Color fundus image, 45° field of view — 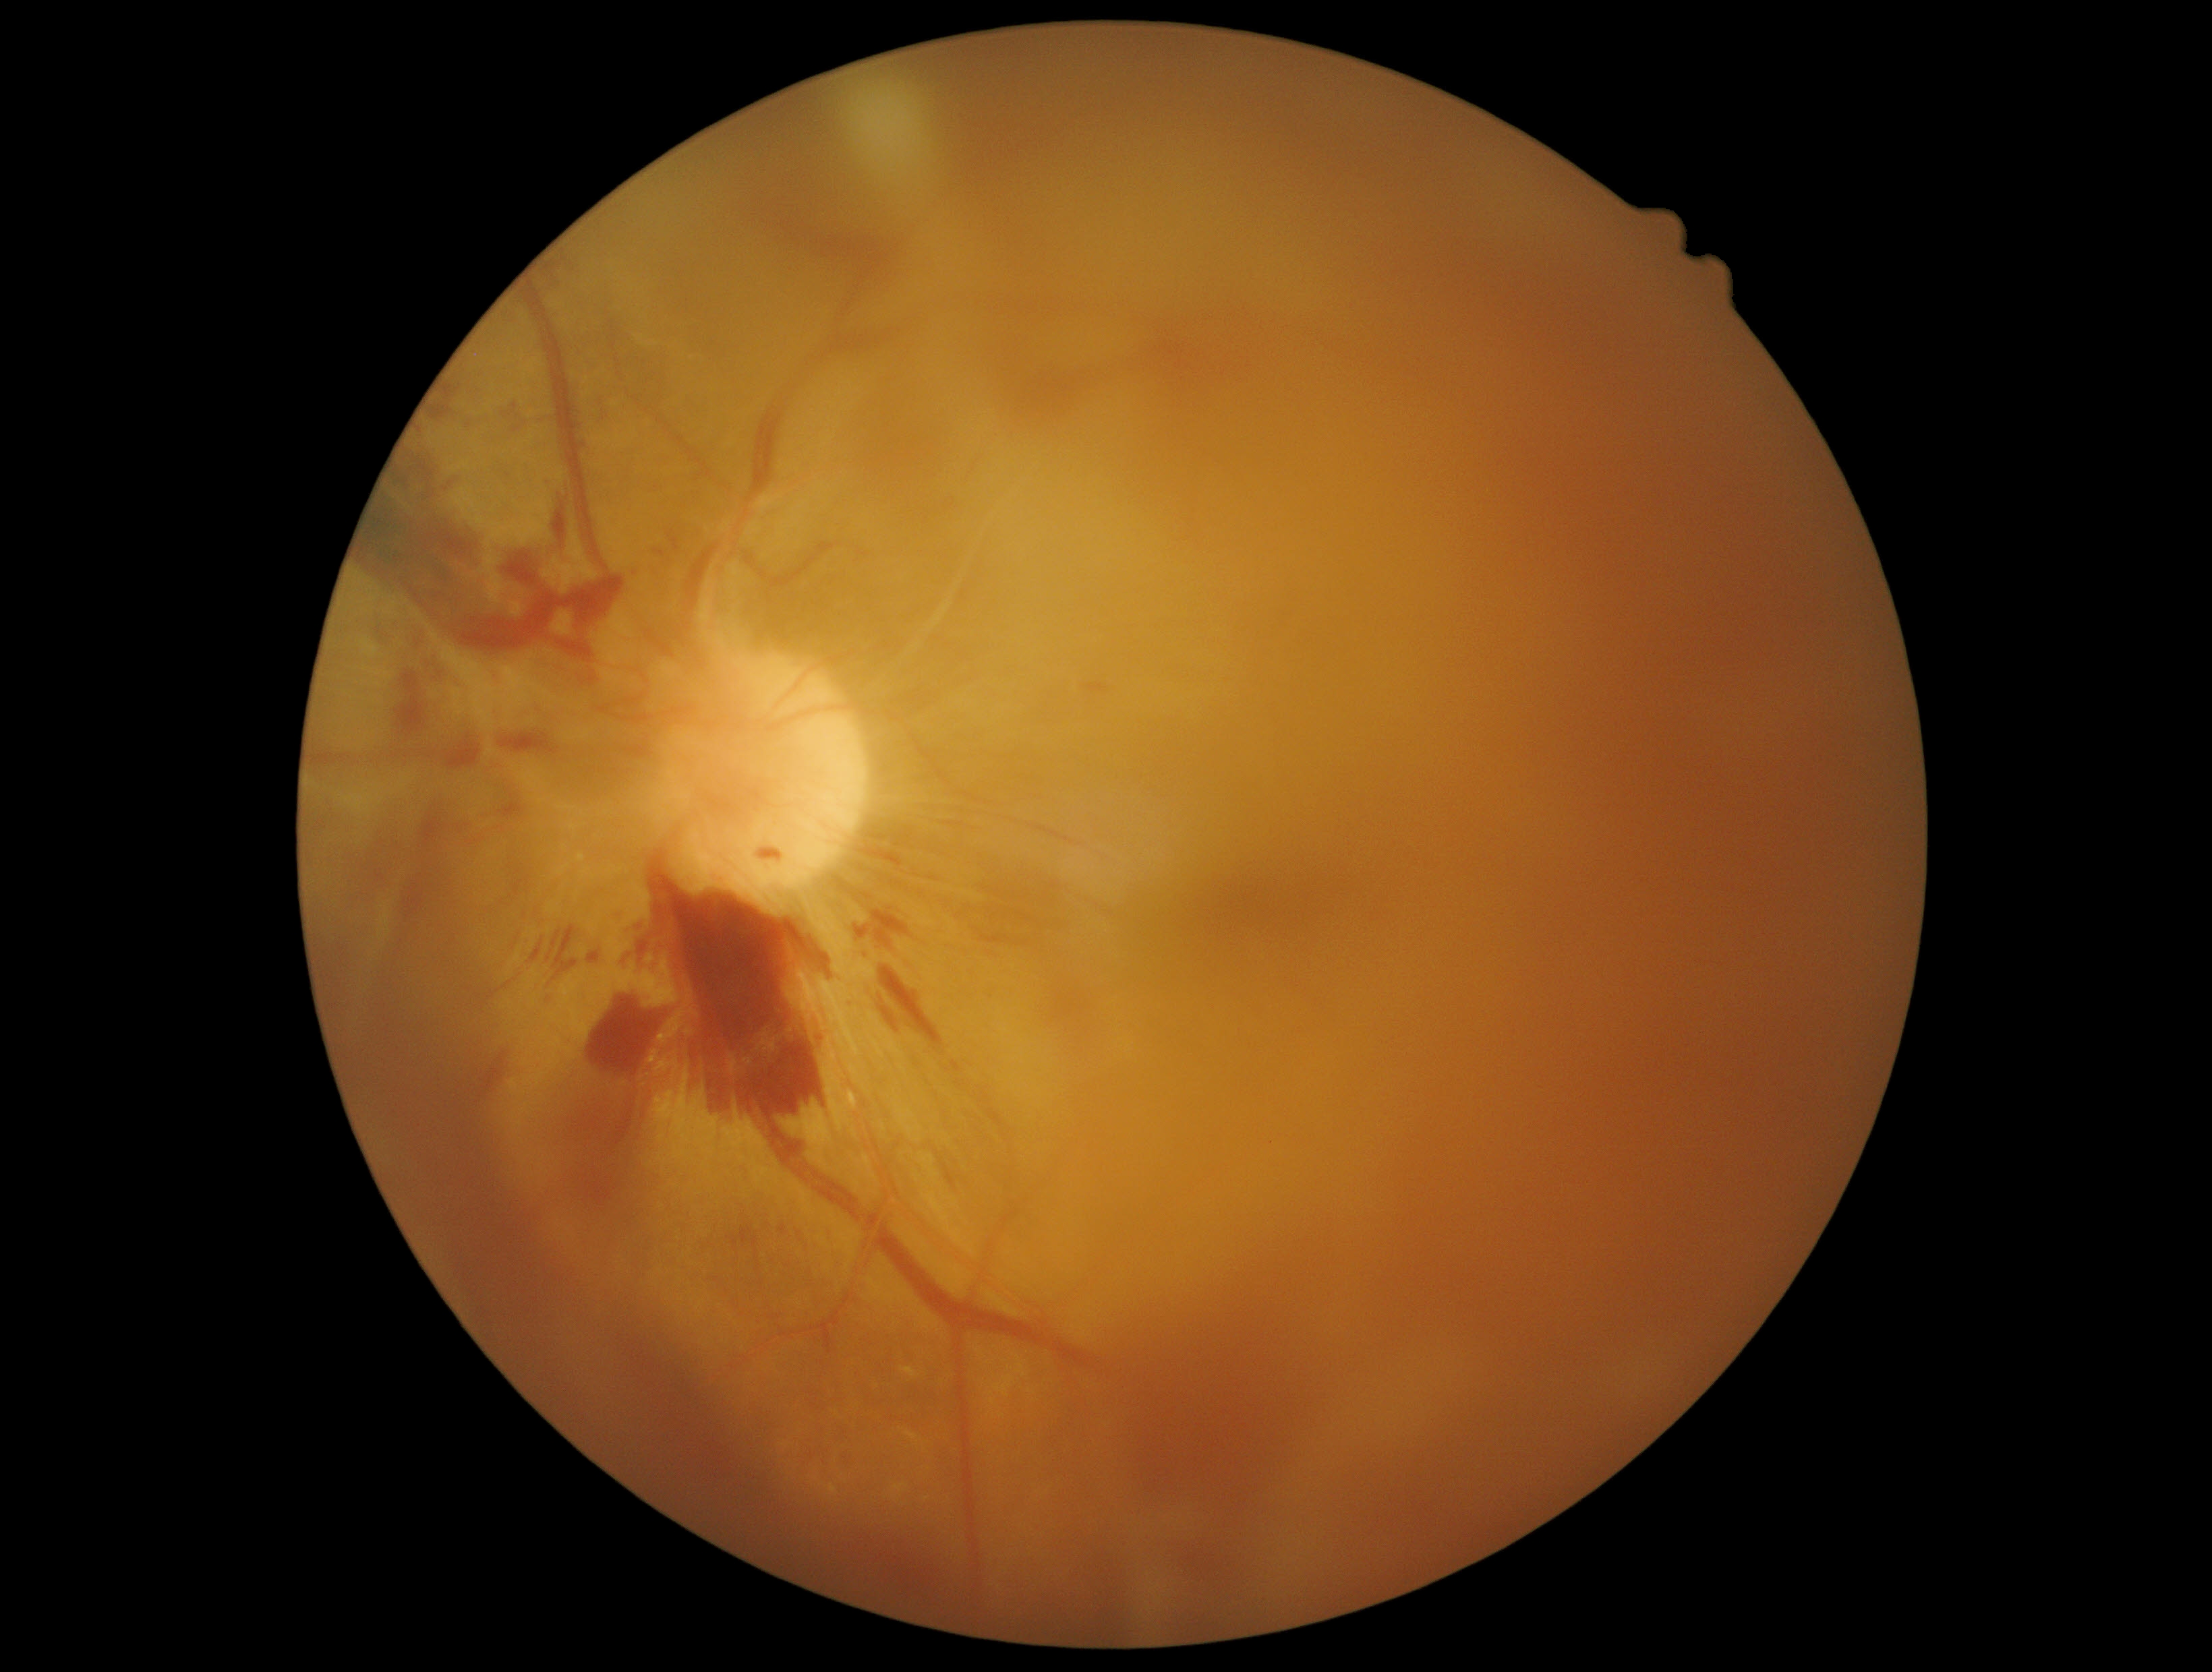
Diabetic retinopathy (DR): grade 4 (PDR)
A subset of detected lesions:
hemorrhages (HEs) (partial): {"left": 879, "top": 965, "right": 950, "bottom": 1058}, {"left": 552, "top": 485, "right": 570, "bottom": 547}, {"left": 392, "top": 843, "right": 403, "bottom": 852}, {"left": 560, "top": 996, "right": 674, "bottom": 1232}, {"left": 547, "top": 924, "right": 581, "bottom": 976}, {"left": 417, "top": 425, "right": 424, "bottom": 435}, {"left": 369, "top": 869, "right": 386, "bottom": 885}, {"left": 858, "top": 864, "right": 910, "bottom": 892}, {"left": 529, "top": 936, "right": 547, "bottom": 965}, {"left": 497, "top": 789, "right": 527, "bottom": 820}, {"left": 457, "top": 1050, "right": 508, "bottom": 1106}, {"left": 587, "top": 951, "right": 601, "bottom": 965}, {"left": 461, "top": 363, "right": 465, "bottom": 371}, {"left": 760, "top": 850, "right": 783, "bottom": 860}
Small HEs approximately at point(432, 458)